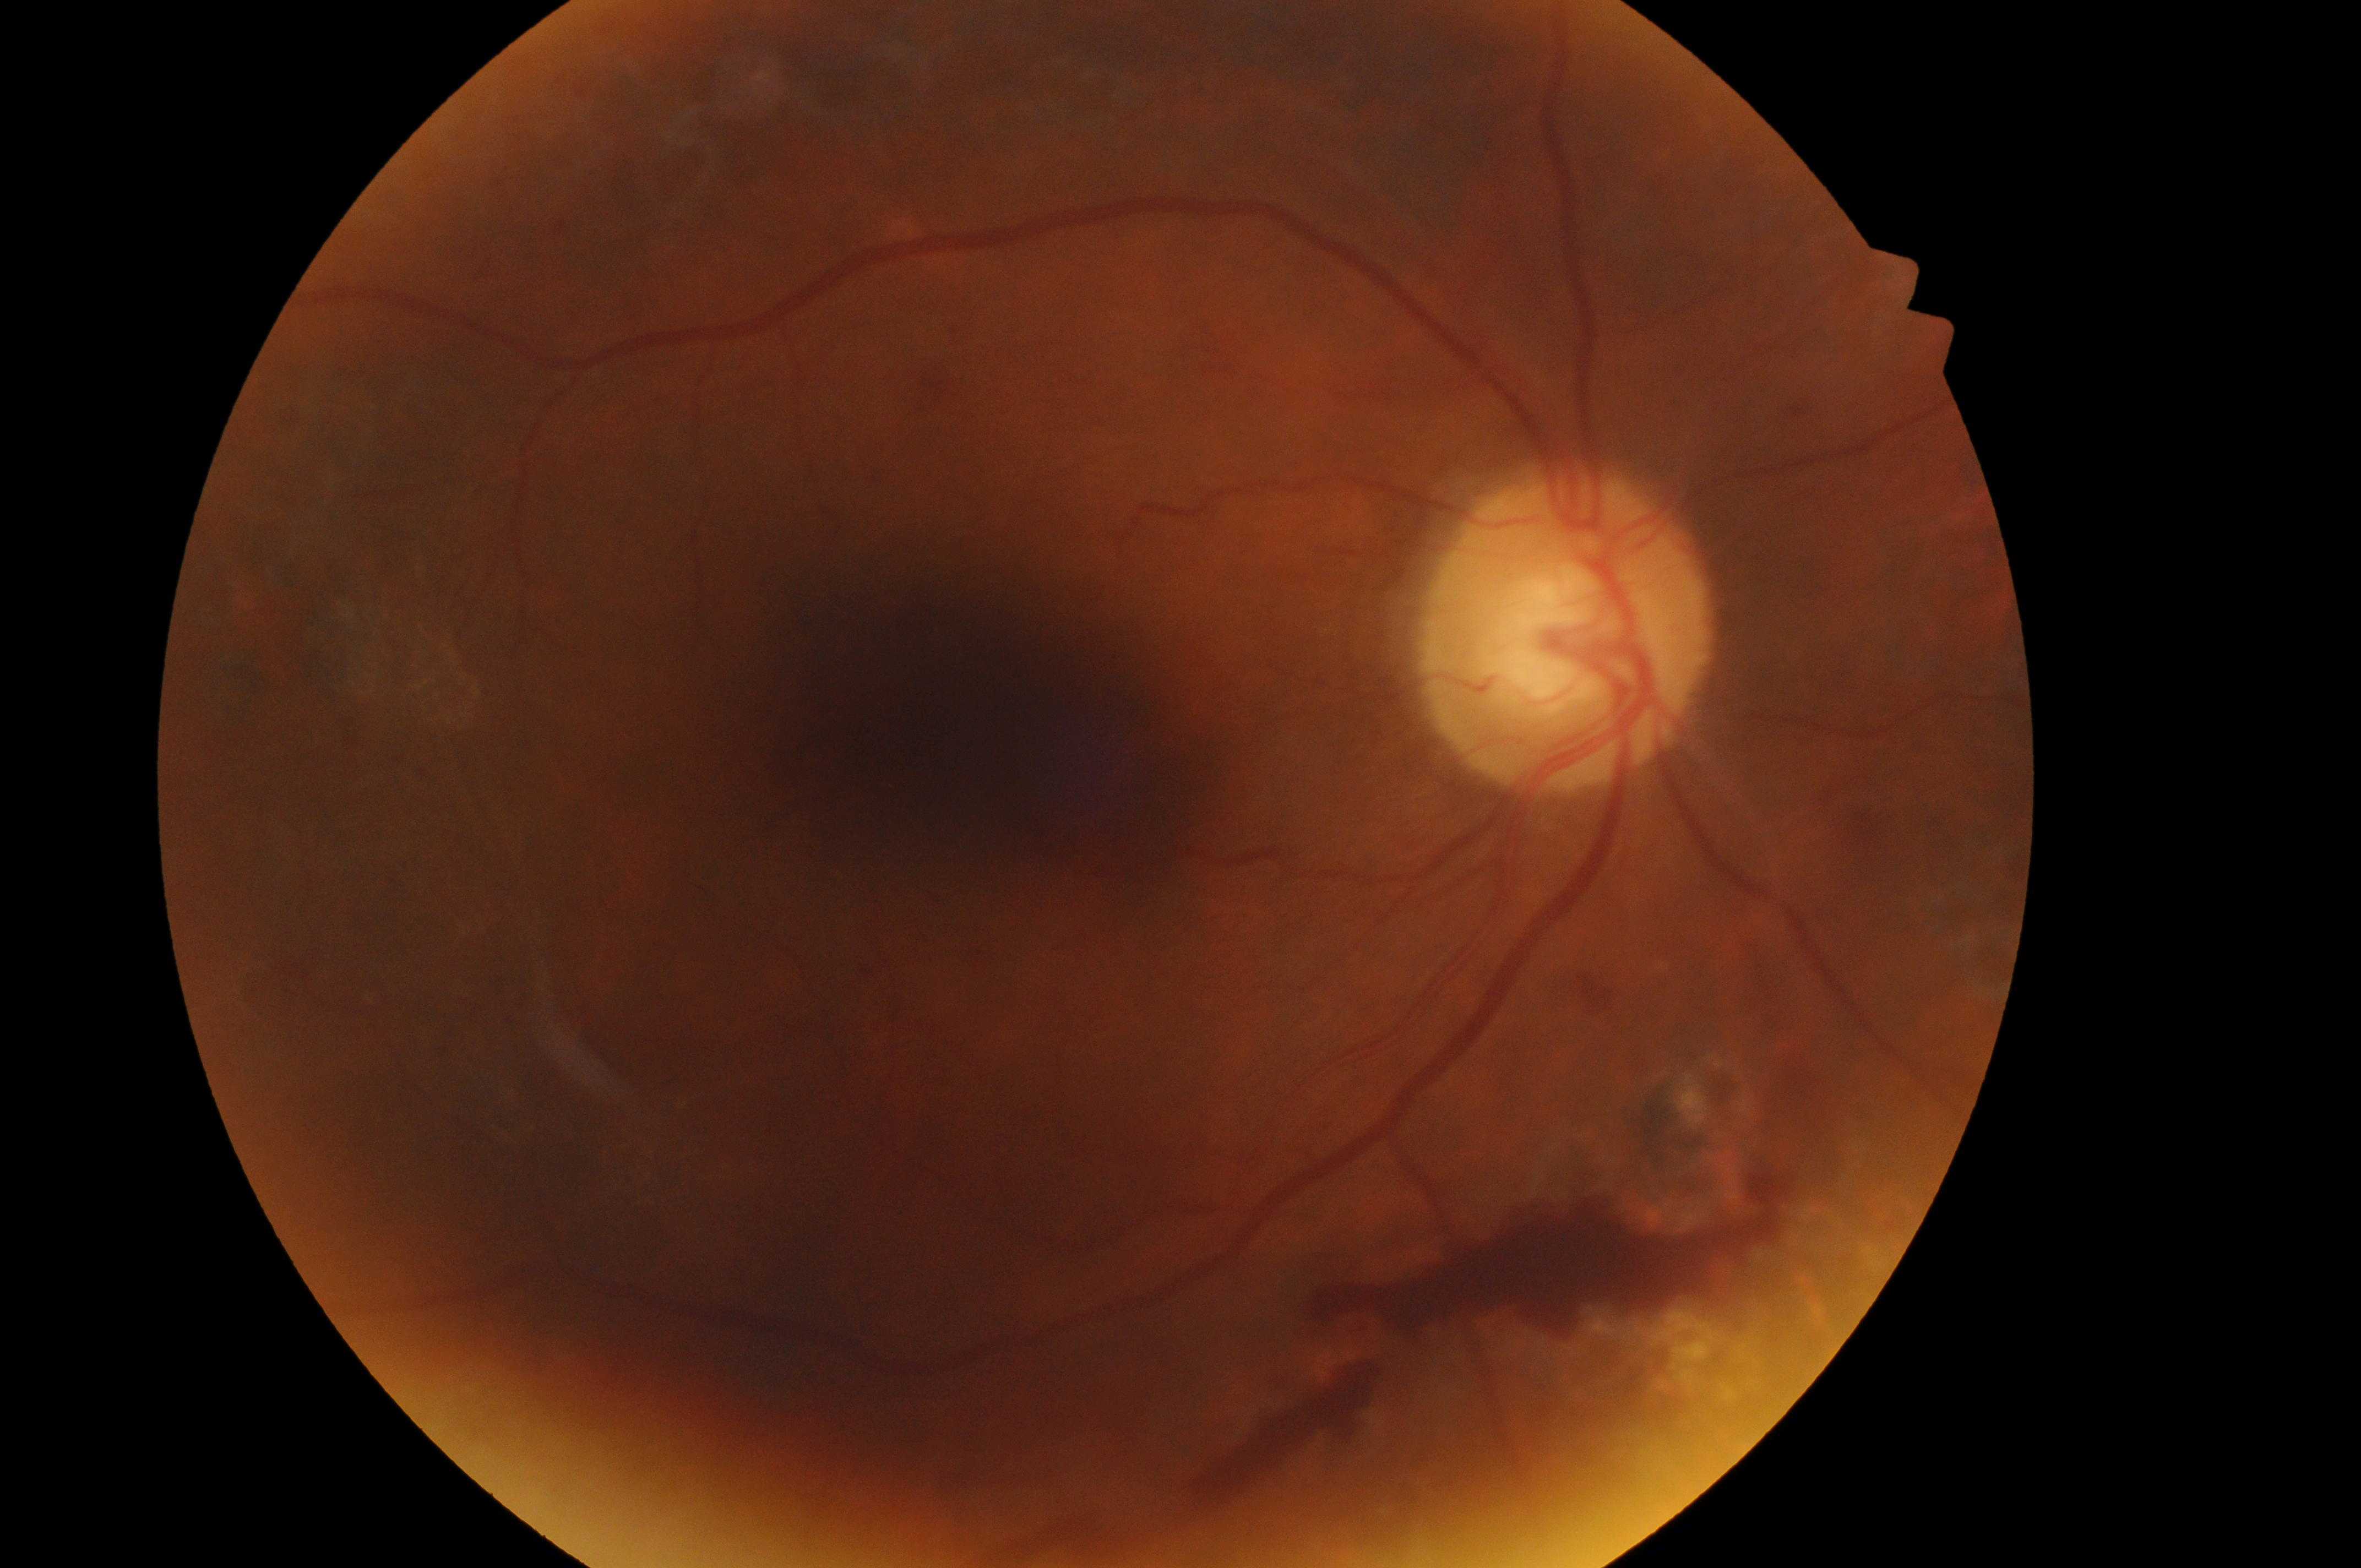

Q: What is the laterality?
A: right
Q: Locate the optic disc.
A: (x: 1564, y: 647)
Q: Diabetic retinopathy severity?
A: PDR (grade 4) — neovascularization and/or vitreous/pre-retinal hemorrhage
Q: Fovea center?
A: (x: 967, y: 721)
Q: What is the DME risk grade?
A: low risk (grade 1) — hard exudates present, but outside one disc diameter of the macula center